DR severity per modified Davis staging — 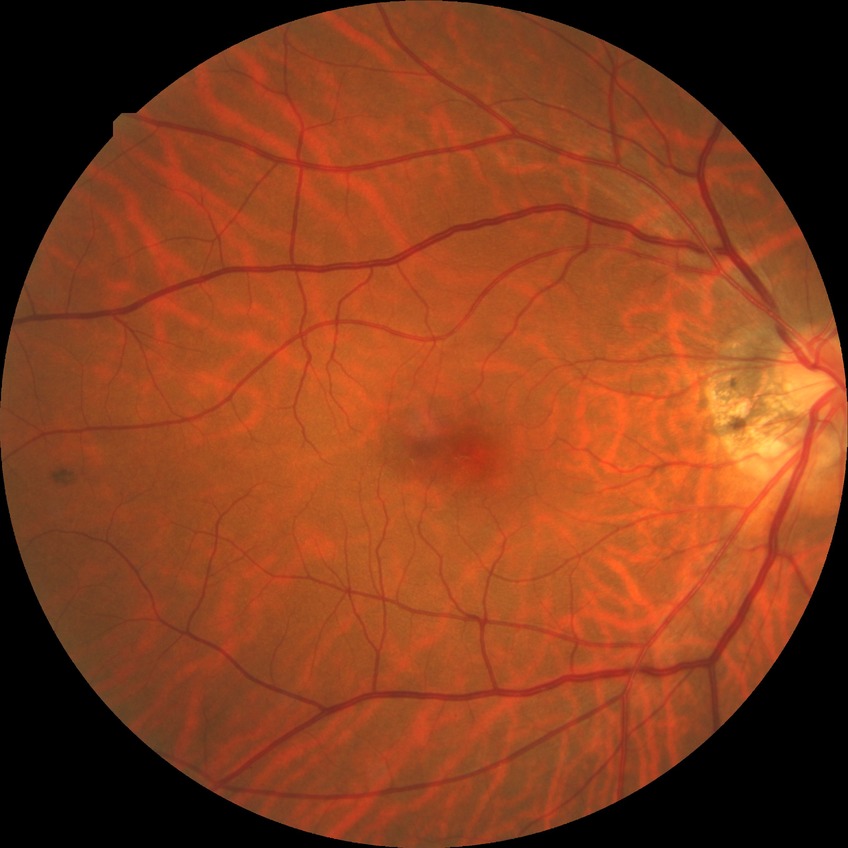 Davis grading@no diabetic retinopathy.